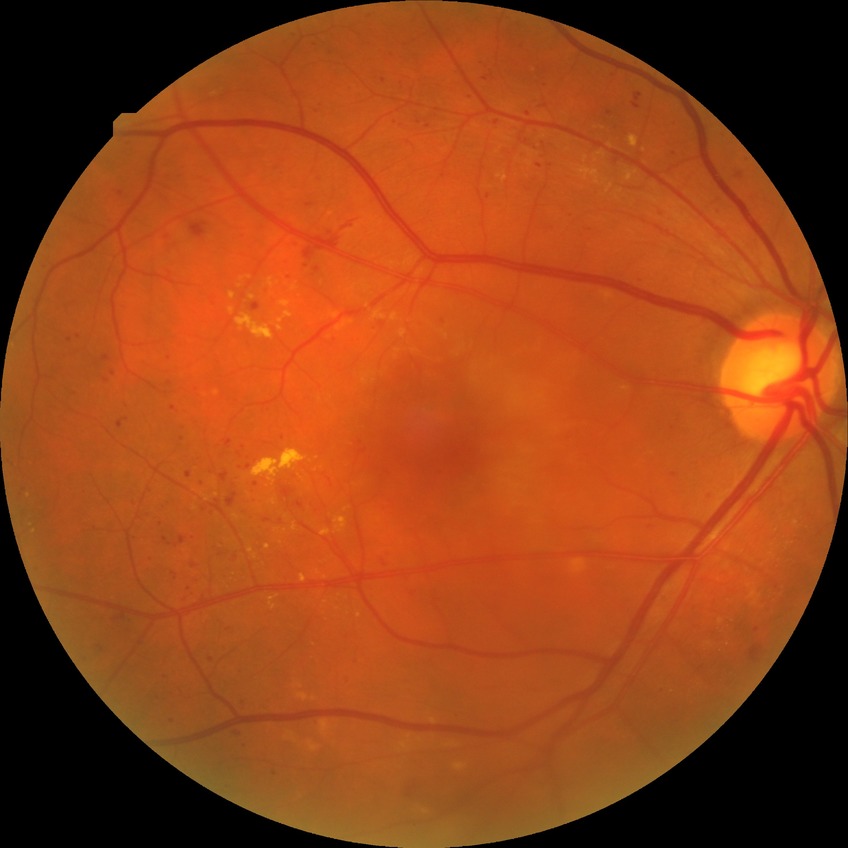
  davis_grade: pre-proliferative diabetic retinopathy